45° FOV — 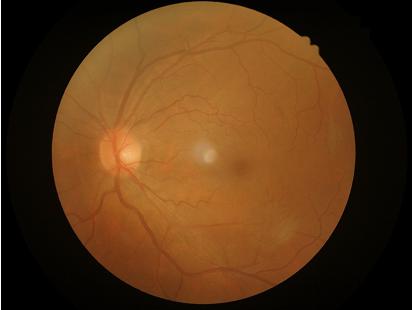
Illumination is even.
Image is sharp throughout the field.
Overall quality is good and the image is gradable.